Optic disc region of a color fundus photo, camera: Topcon TRC, 35° field of view before cropping
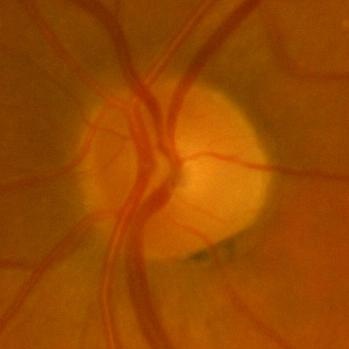
The image shows no glaucomatous changes.